Ultra-widefield fundus mosaic, 1924x1556px — 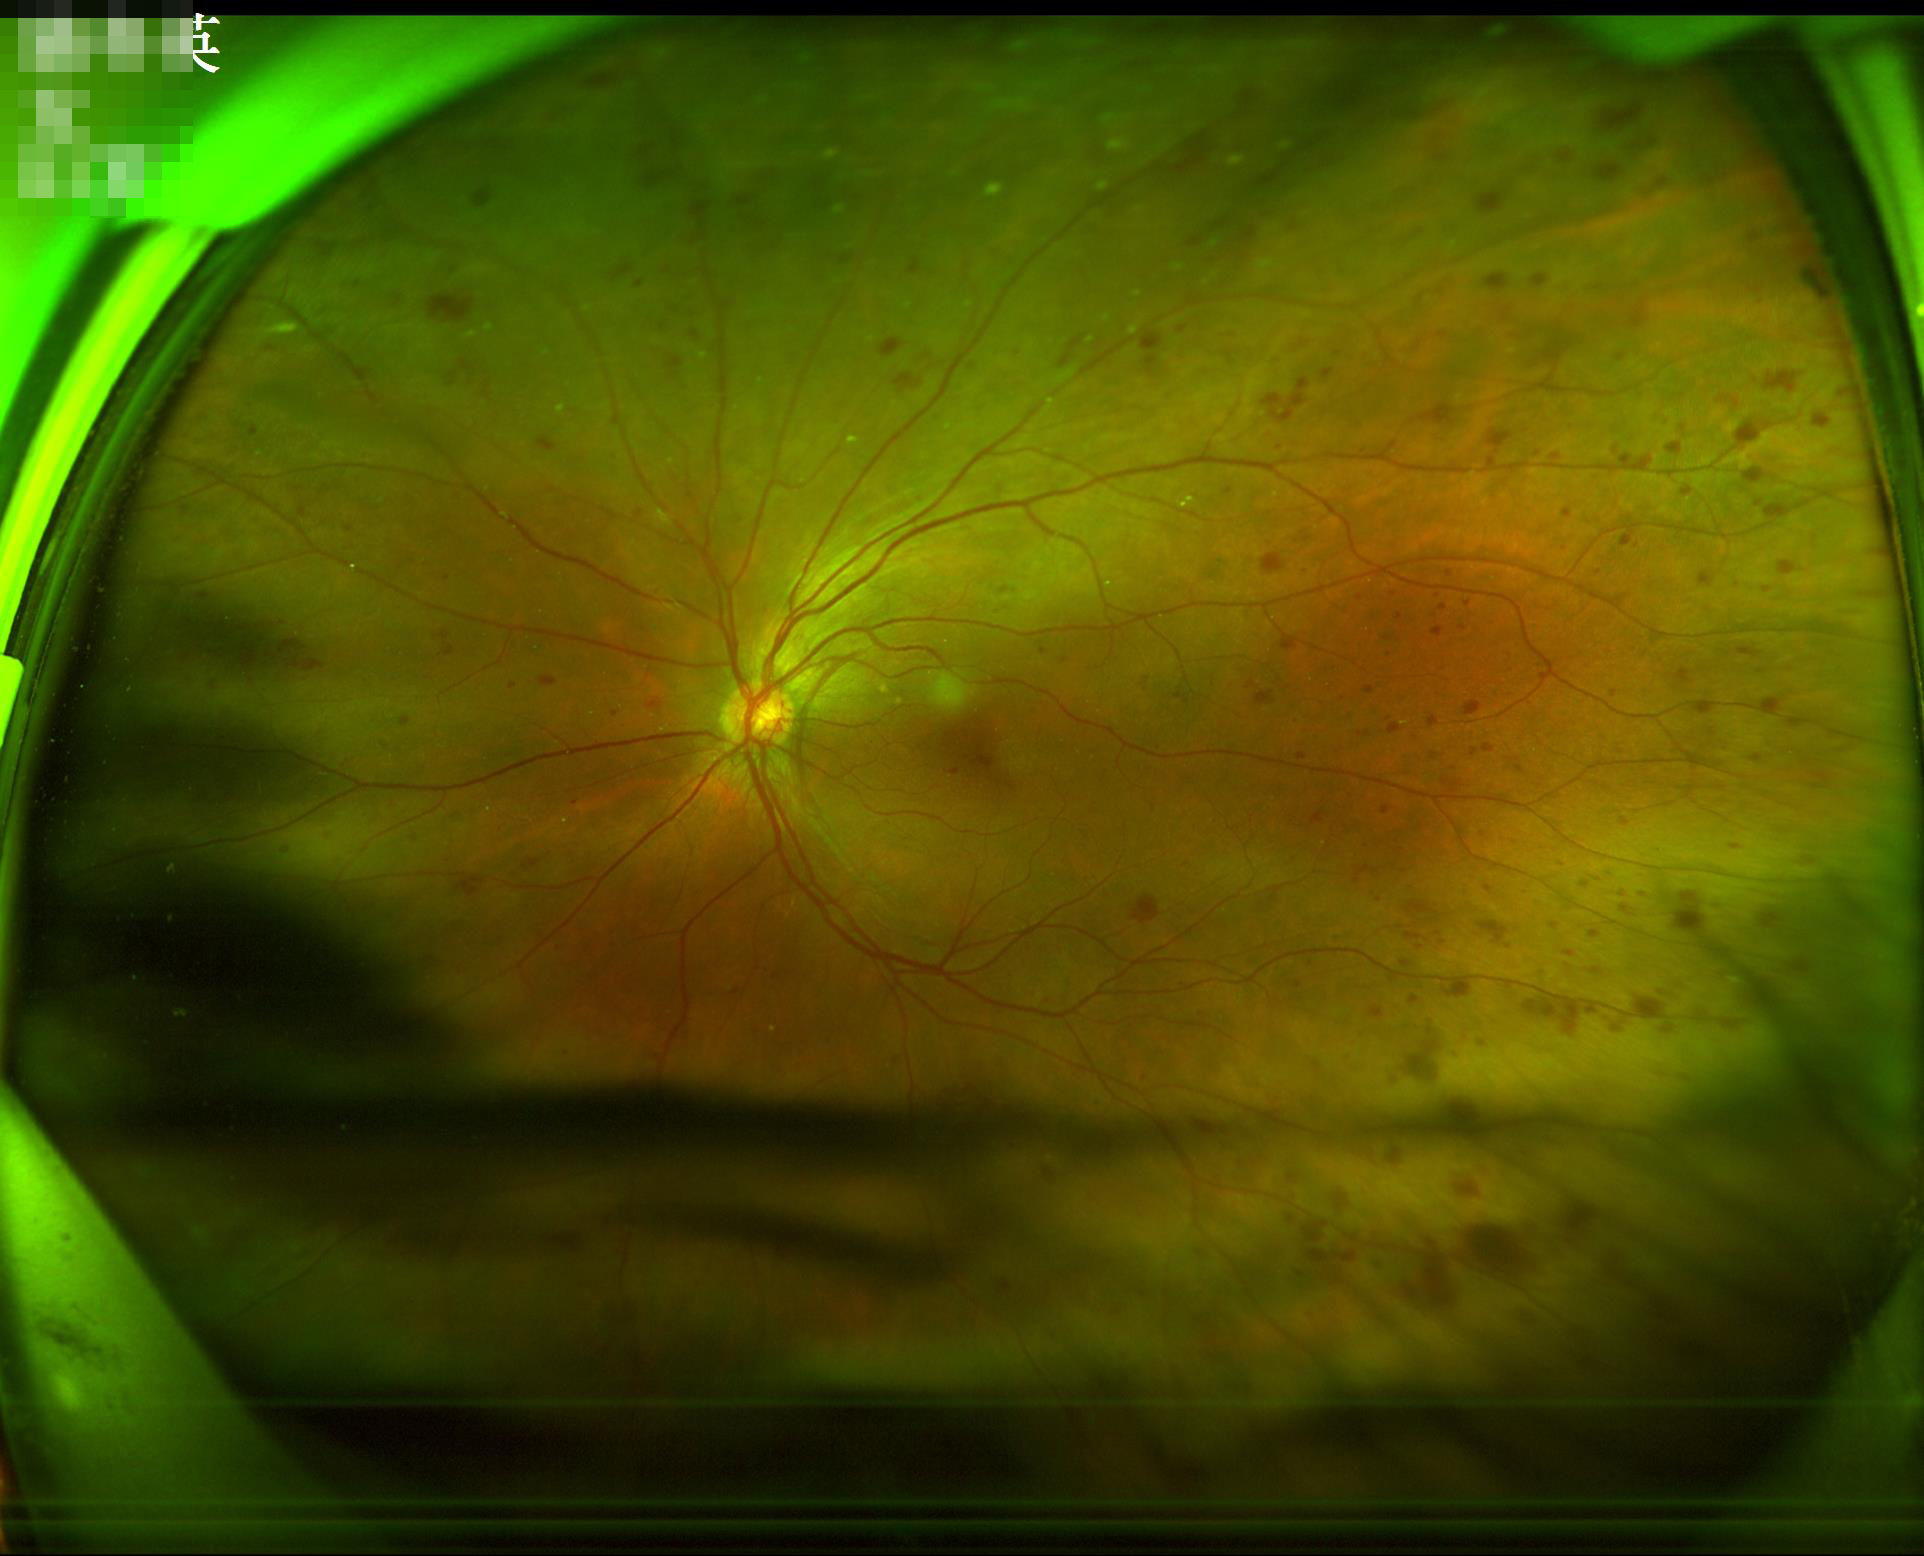

The image is clear. Illumination and color are suboptimal.